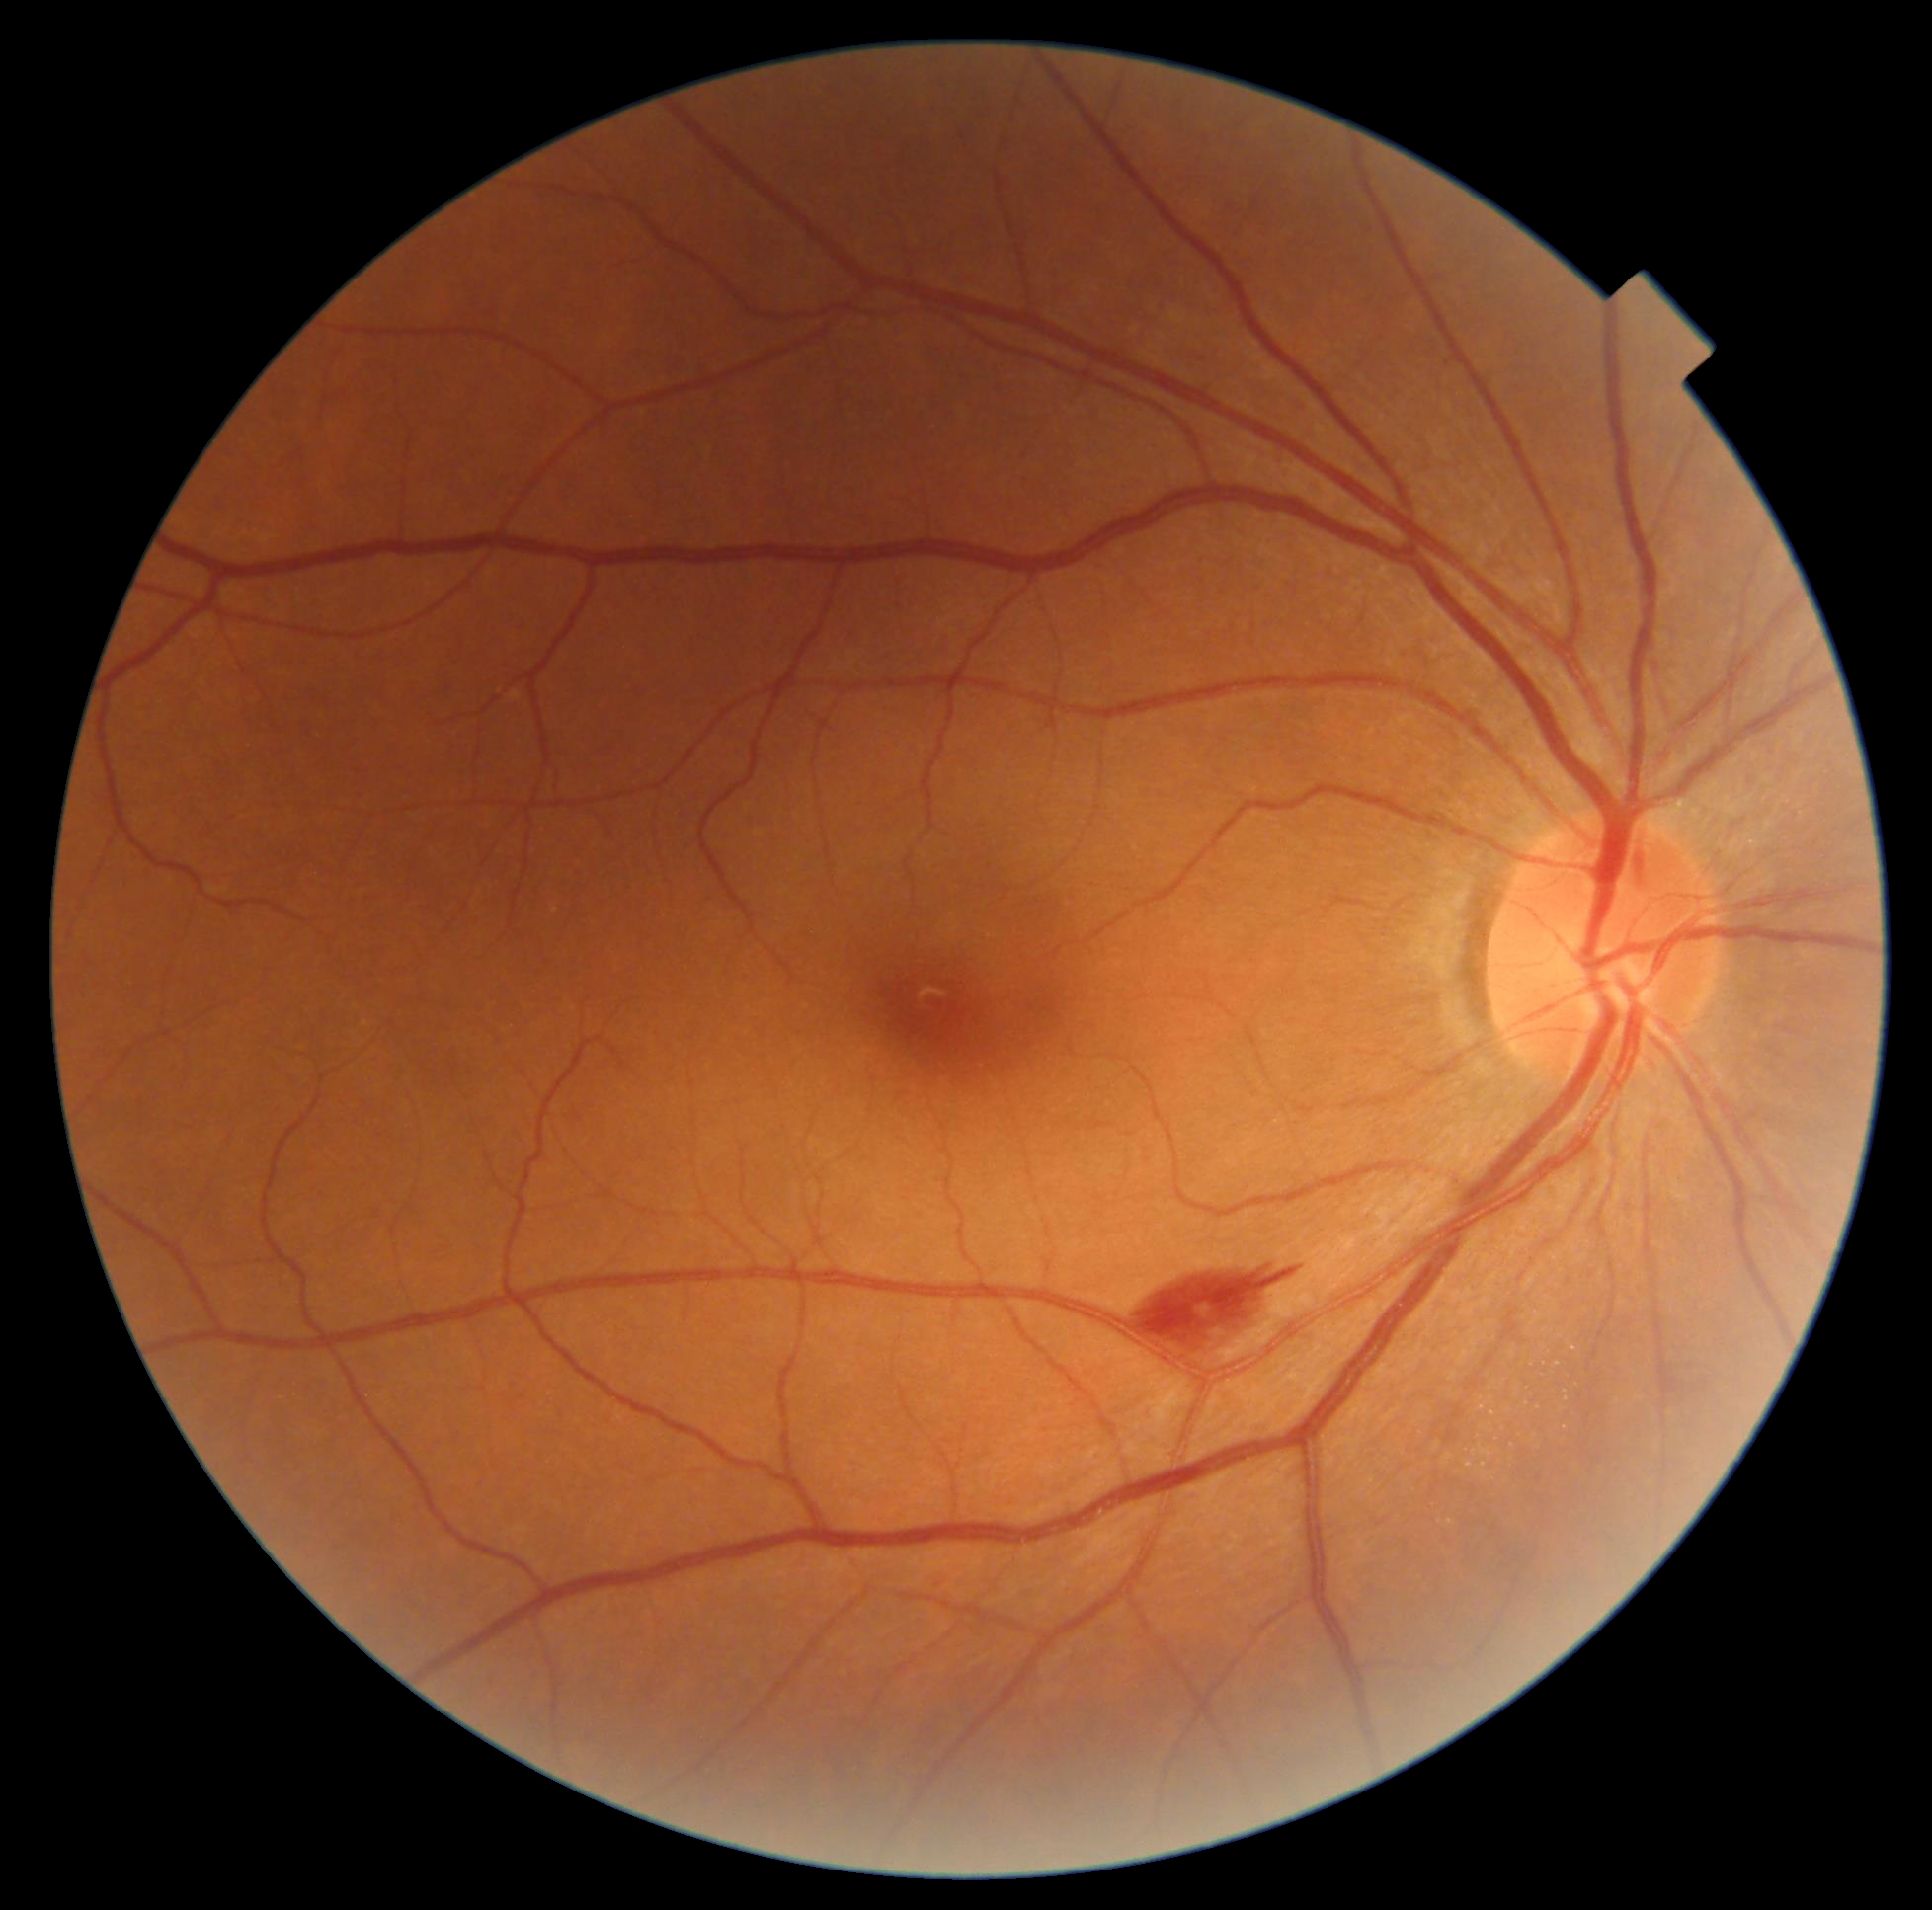 diabetic retinopathy grade: 2 (moderate NPDR).